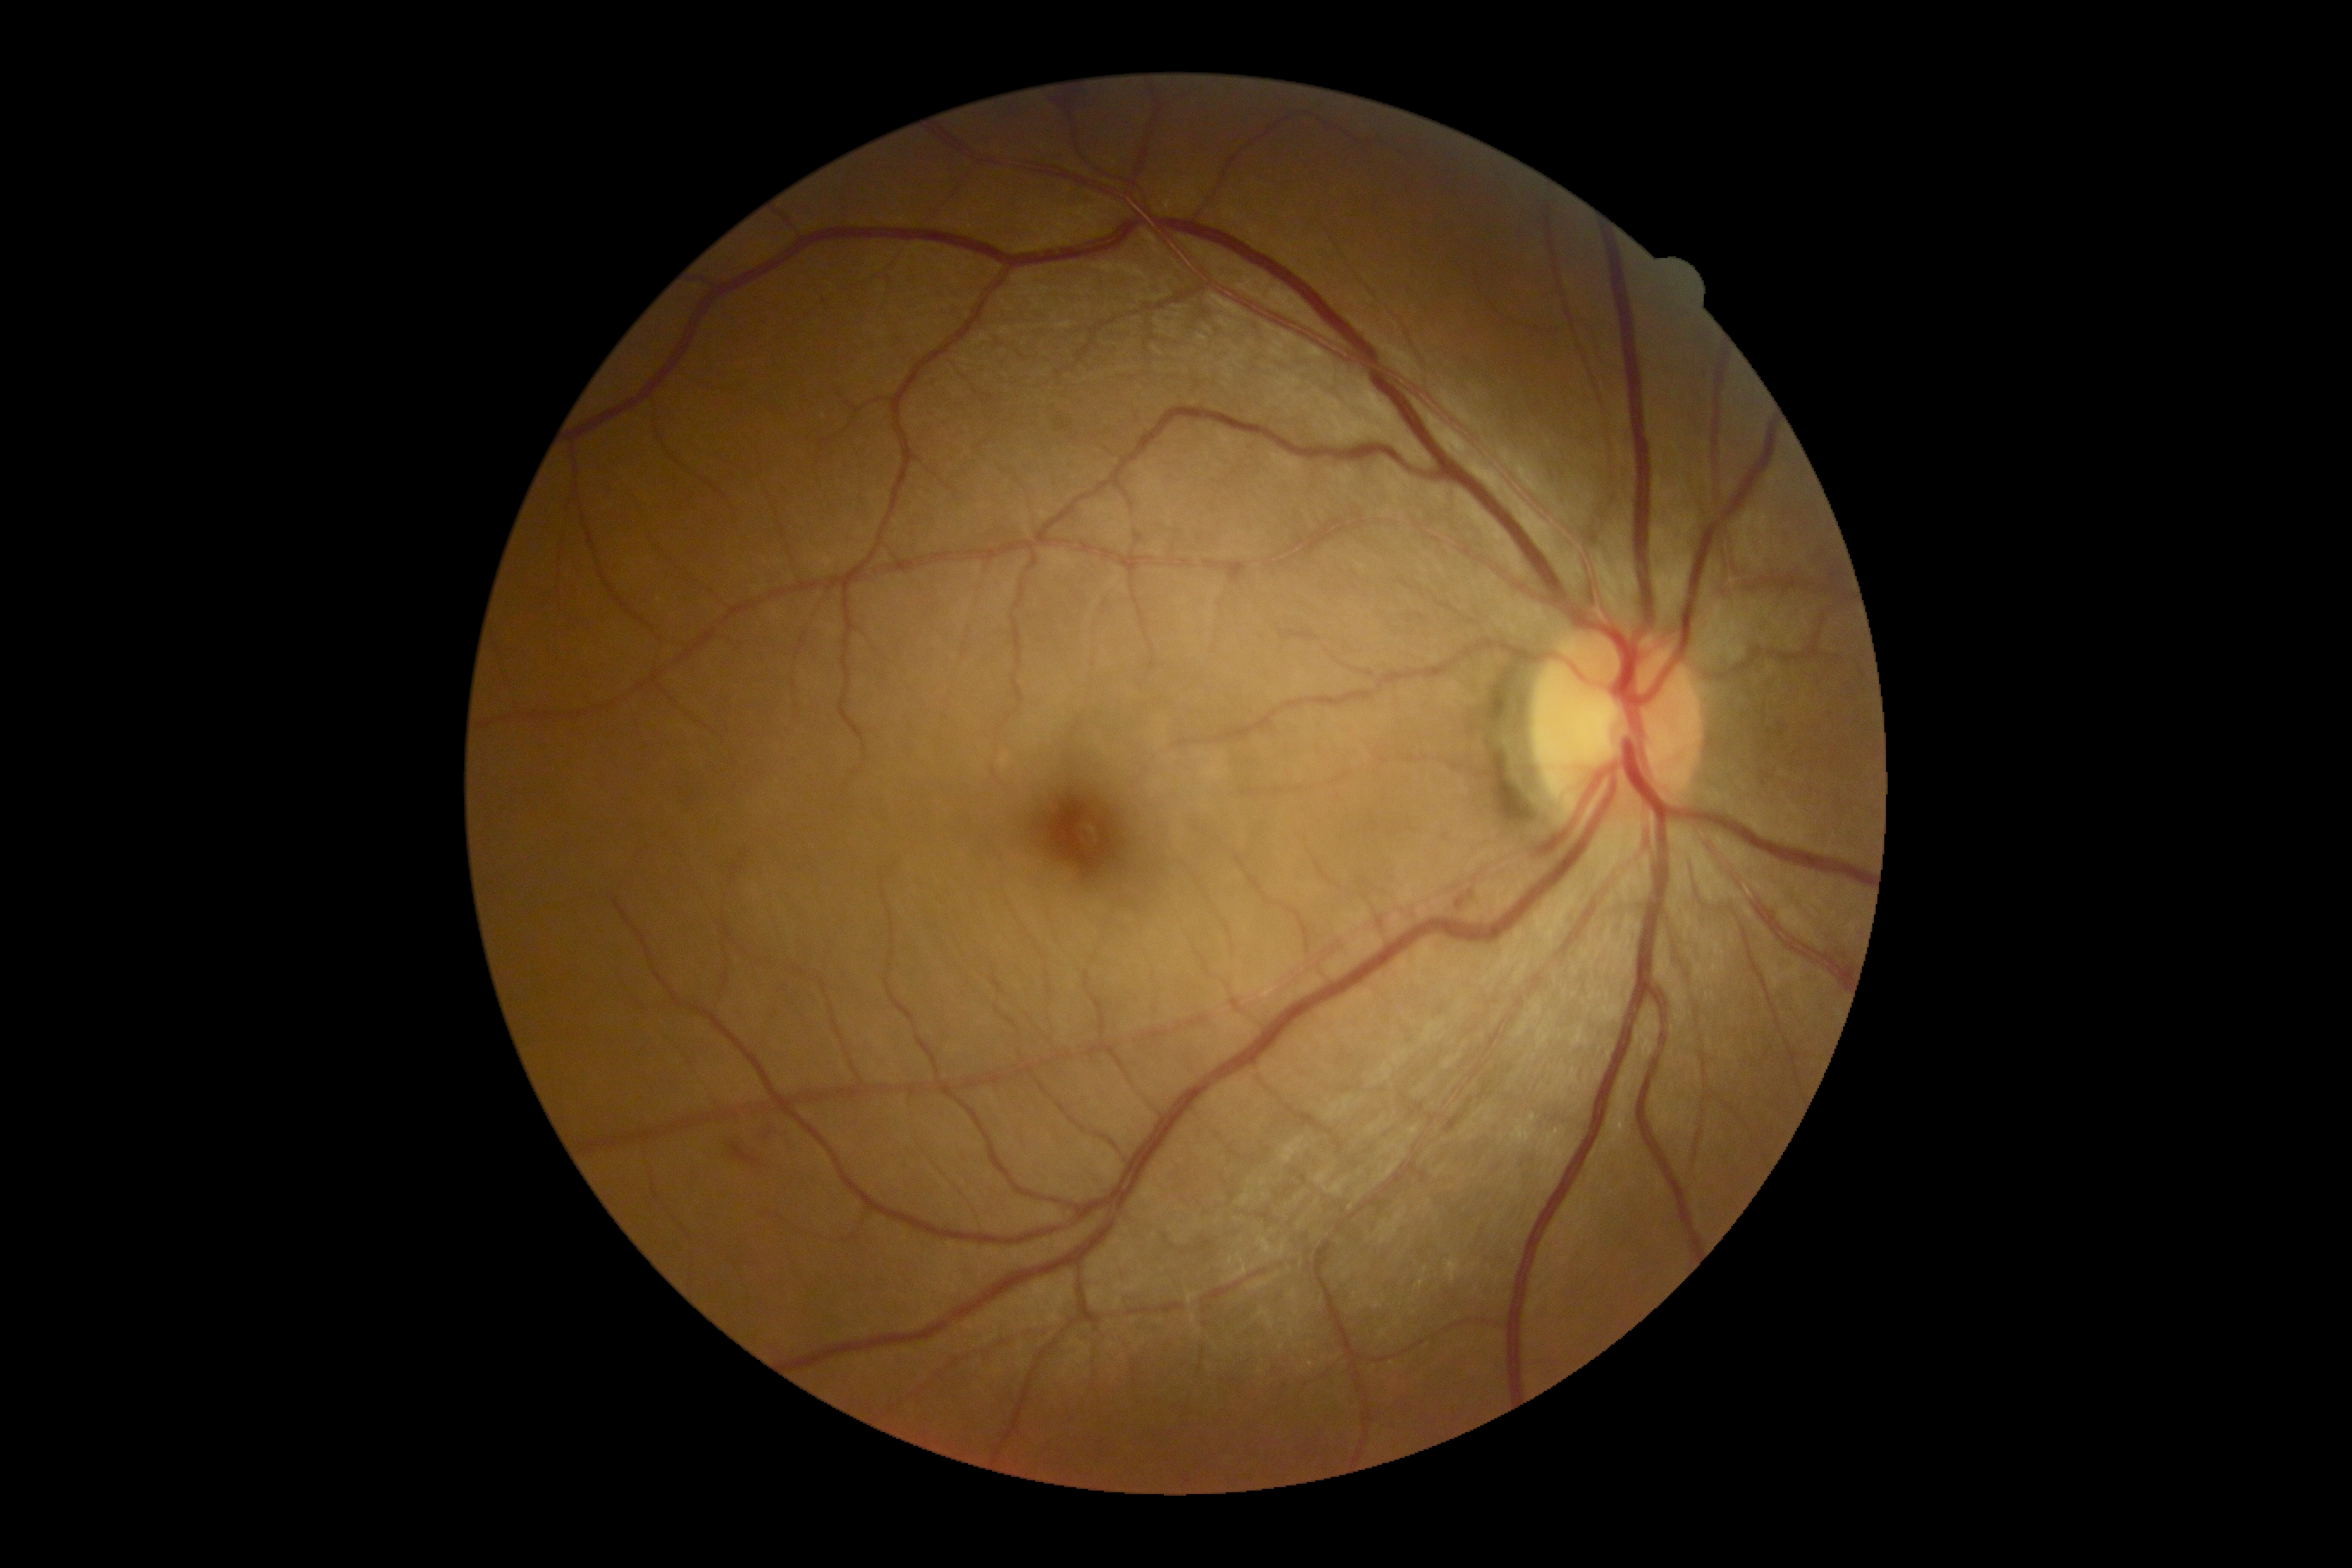 DR severity is grade 2.